Camera: NIDEK AFC-230 · 848x848 — 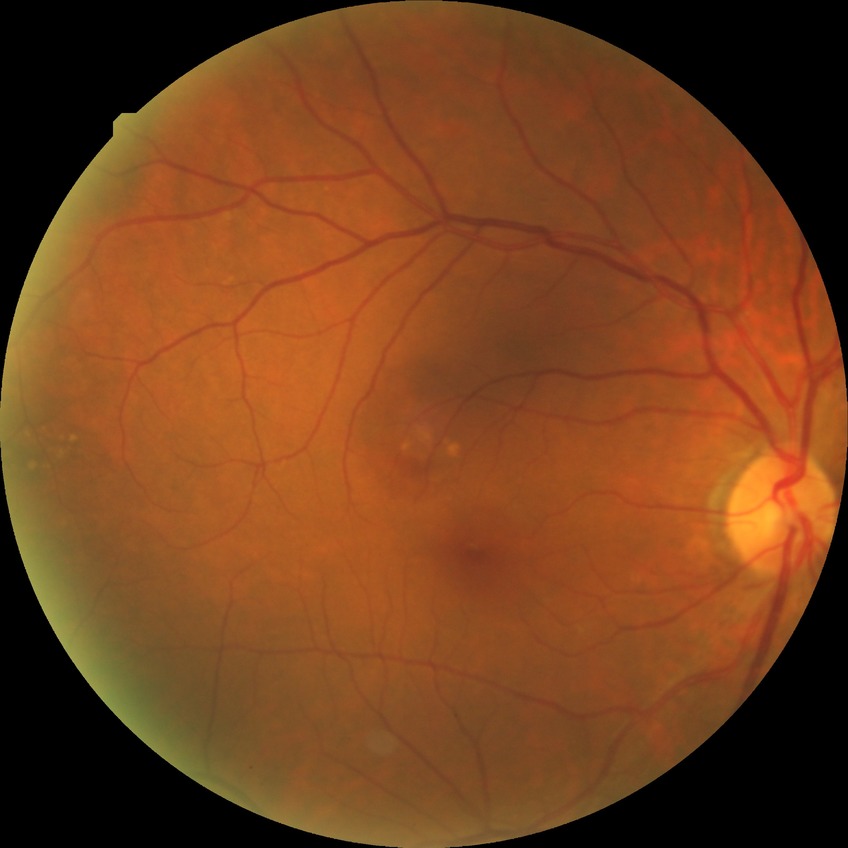

modified Davis grading@no diabetic retinopathy.